Color fundus image:
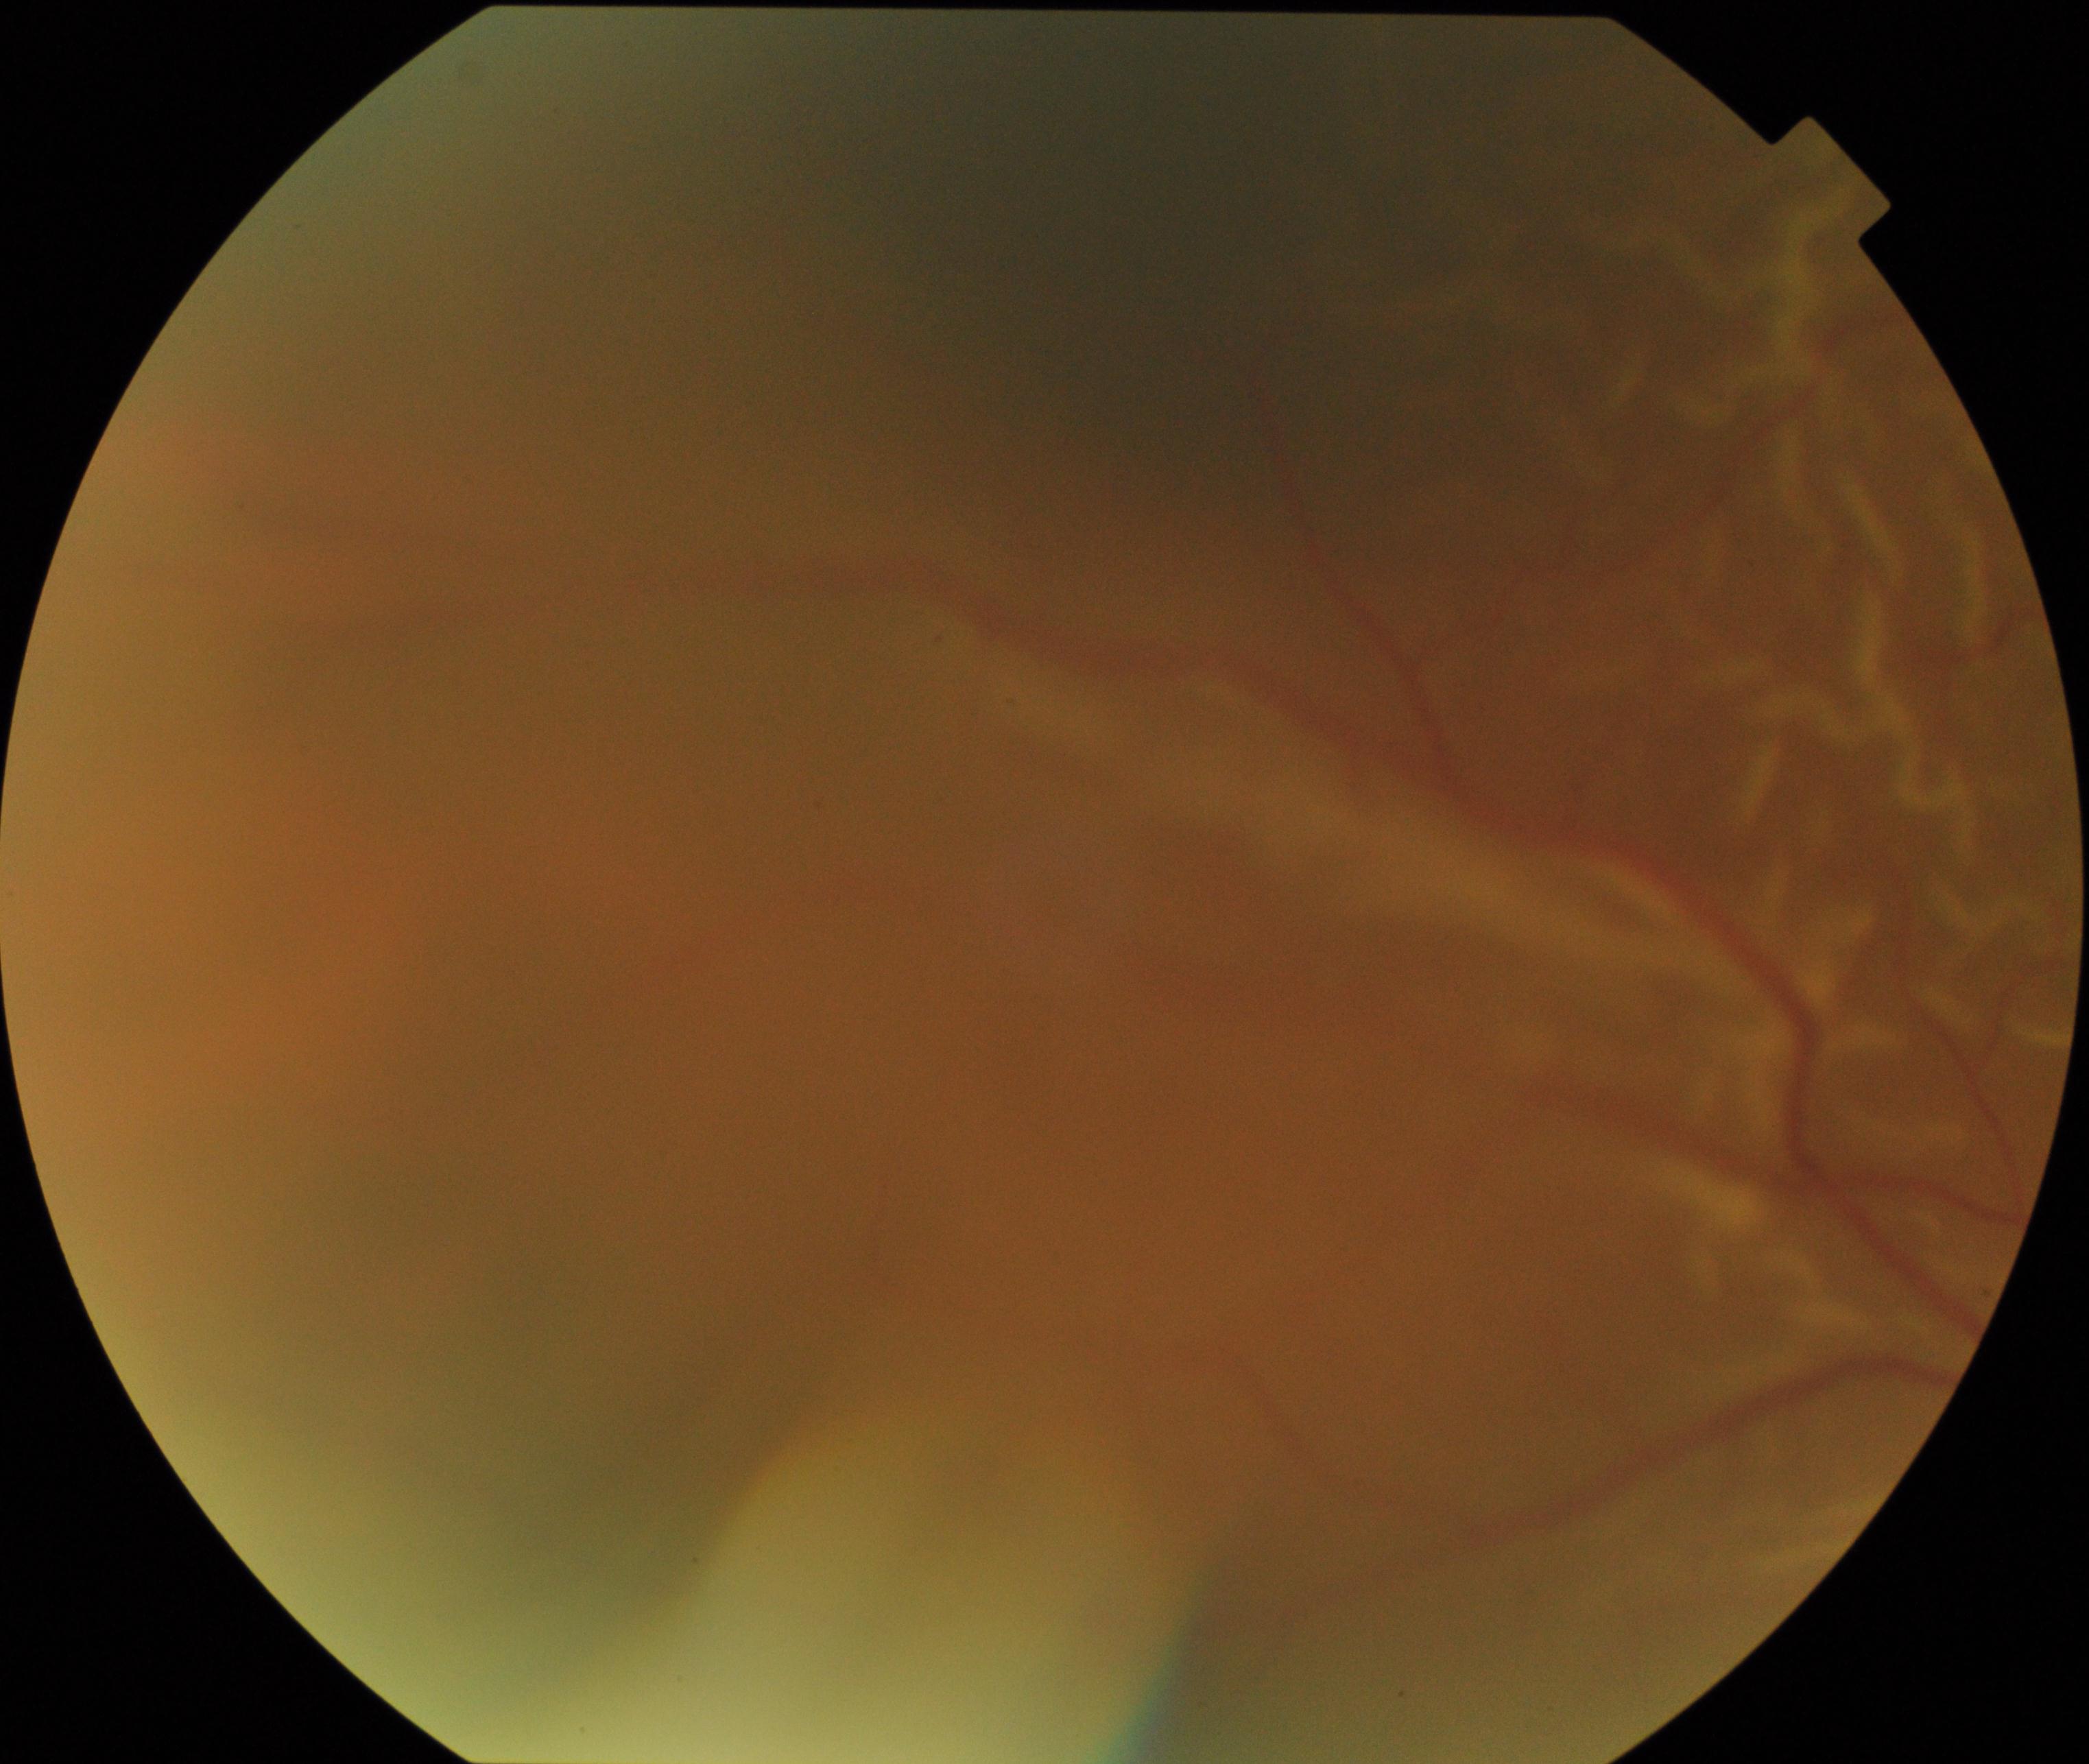

The image shows rhegmatogenous retinal detachment.